NIDEK AFC-230 fundus camera — 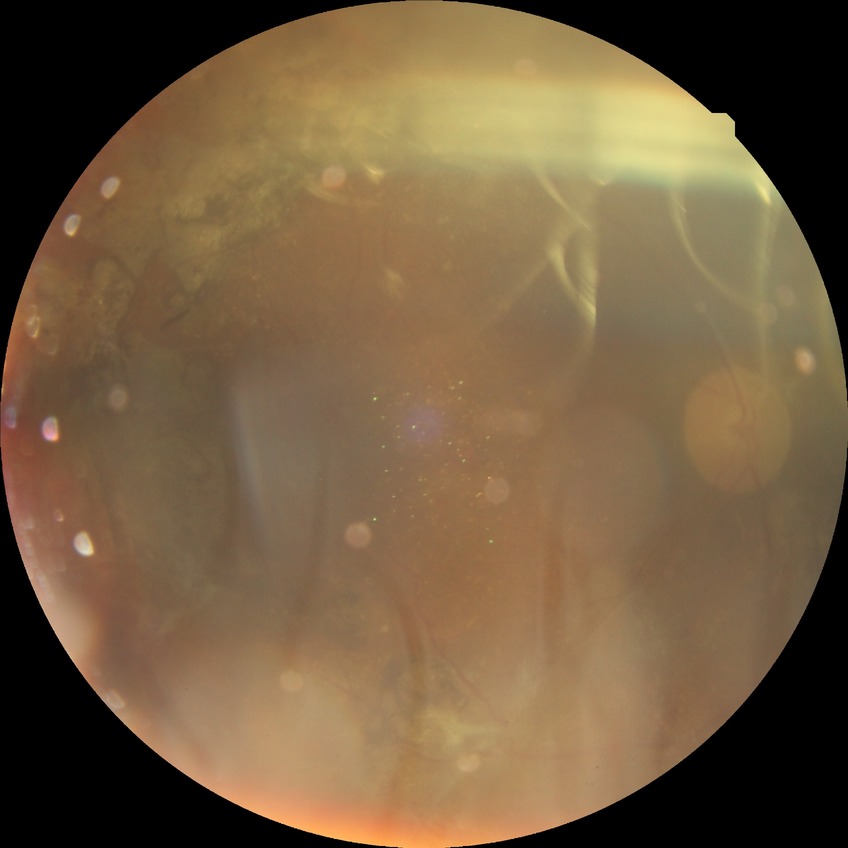 Davis grading: proliferative diabetic retinopathy.